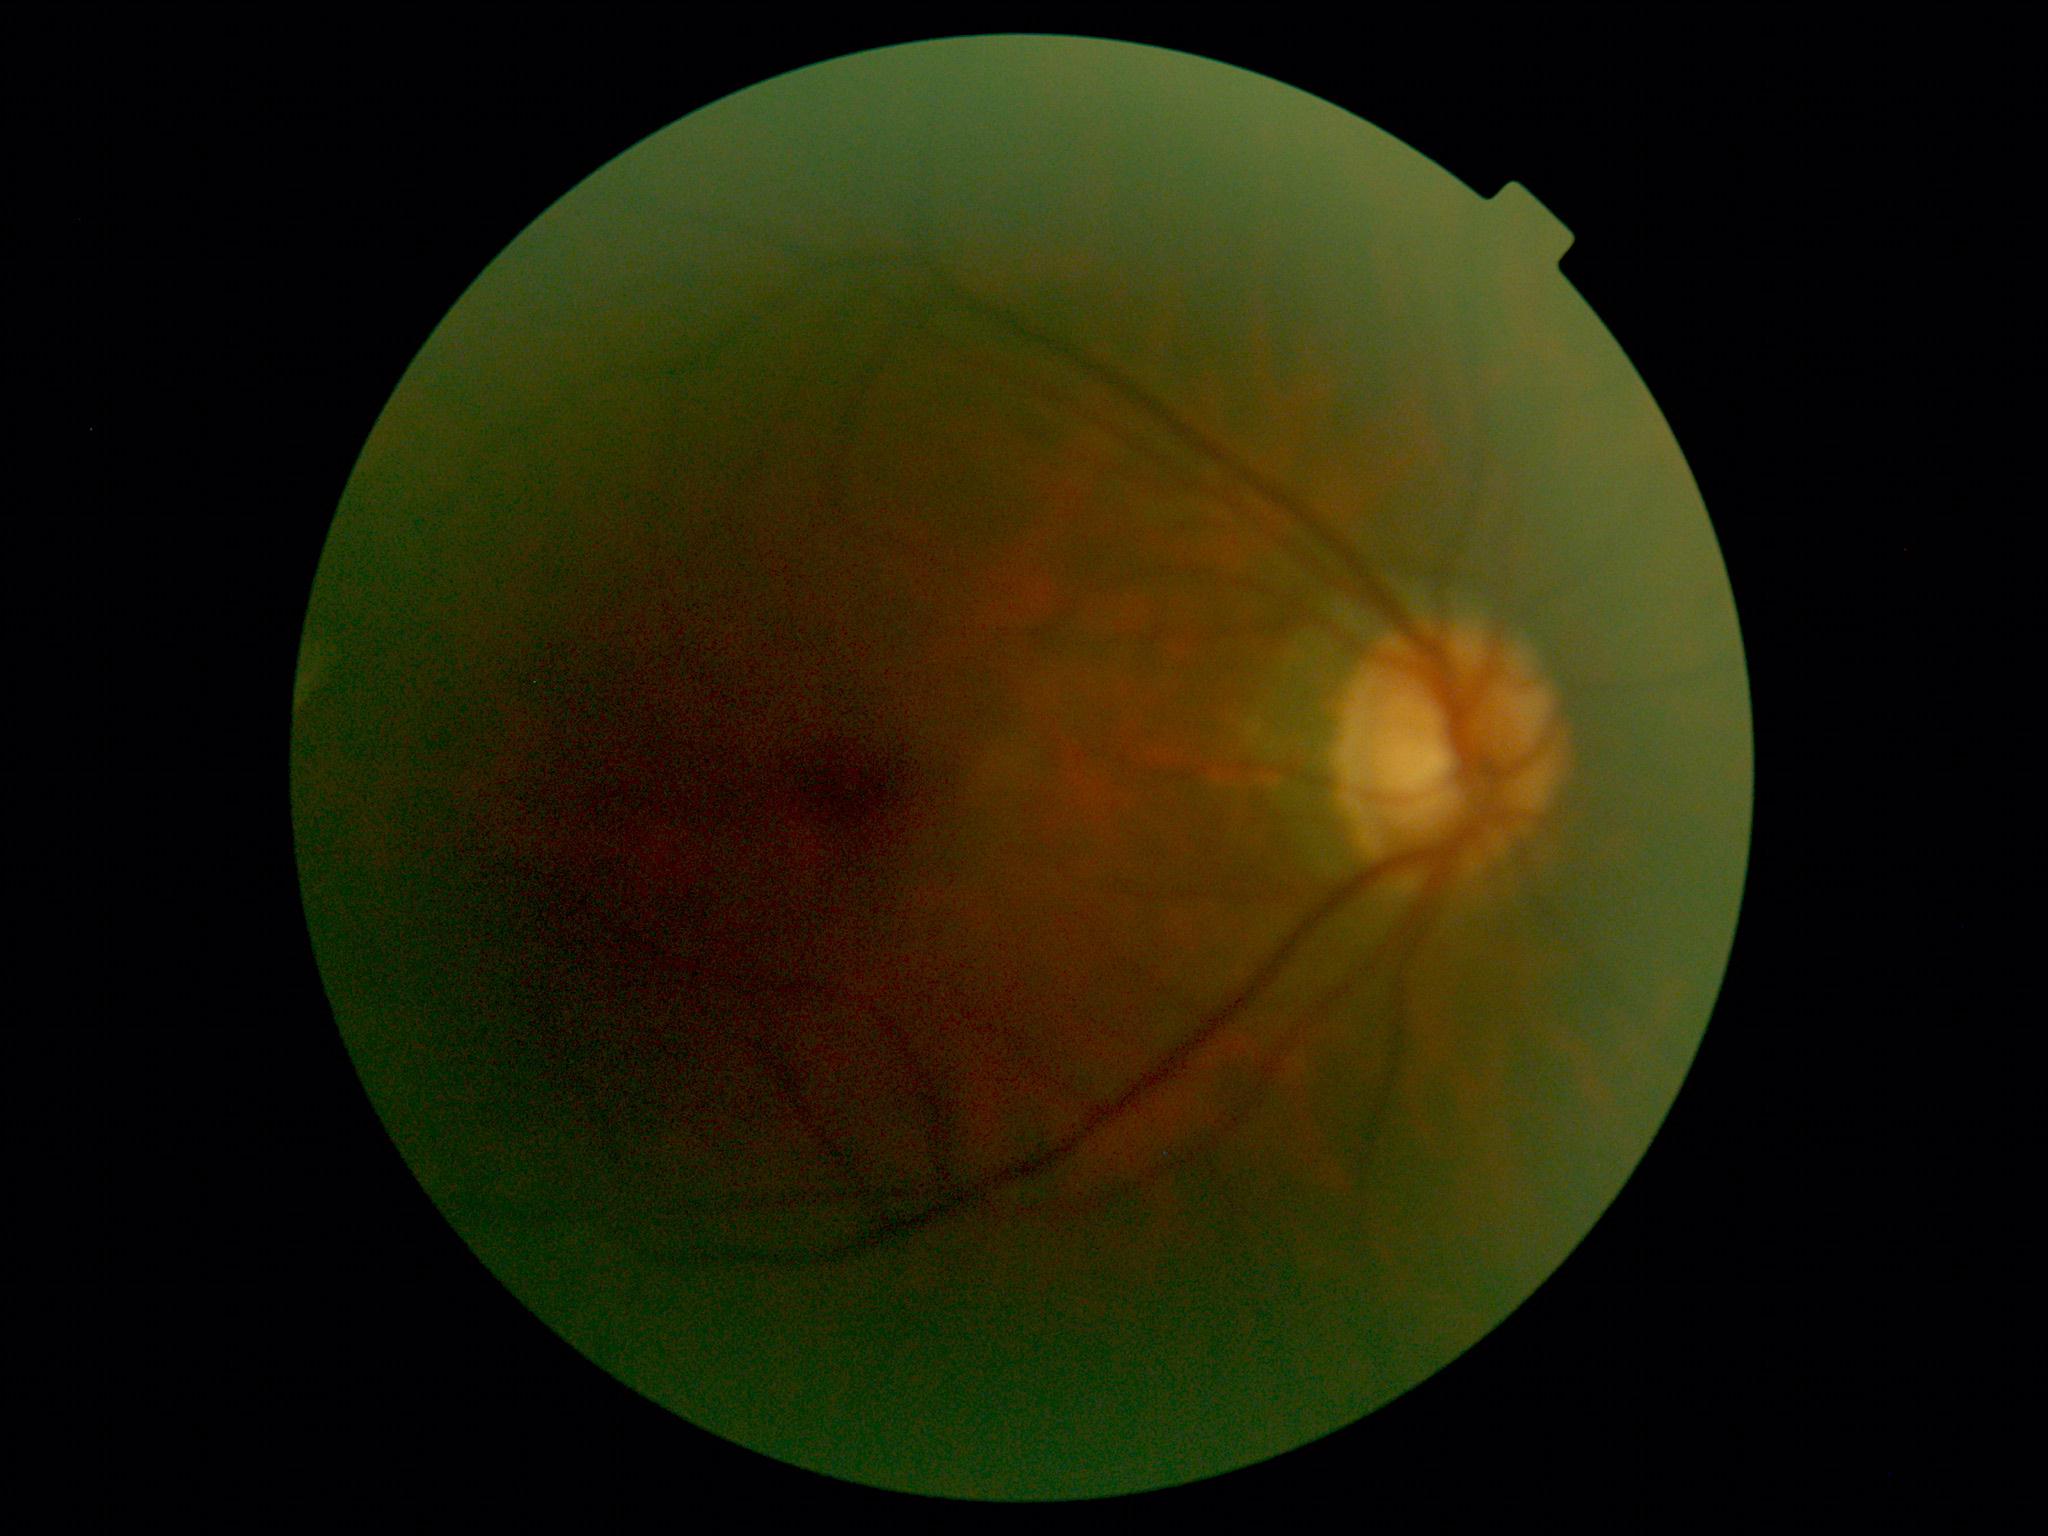

No diabetic retinal disease findings. DR grade is 0 (no apparent retinopathy).